2352x1568:
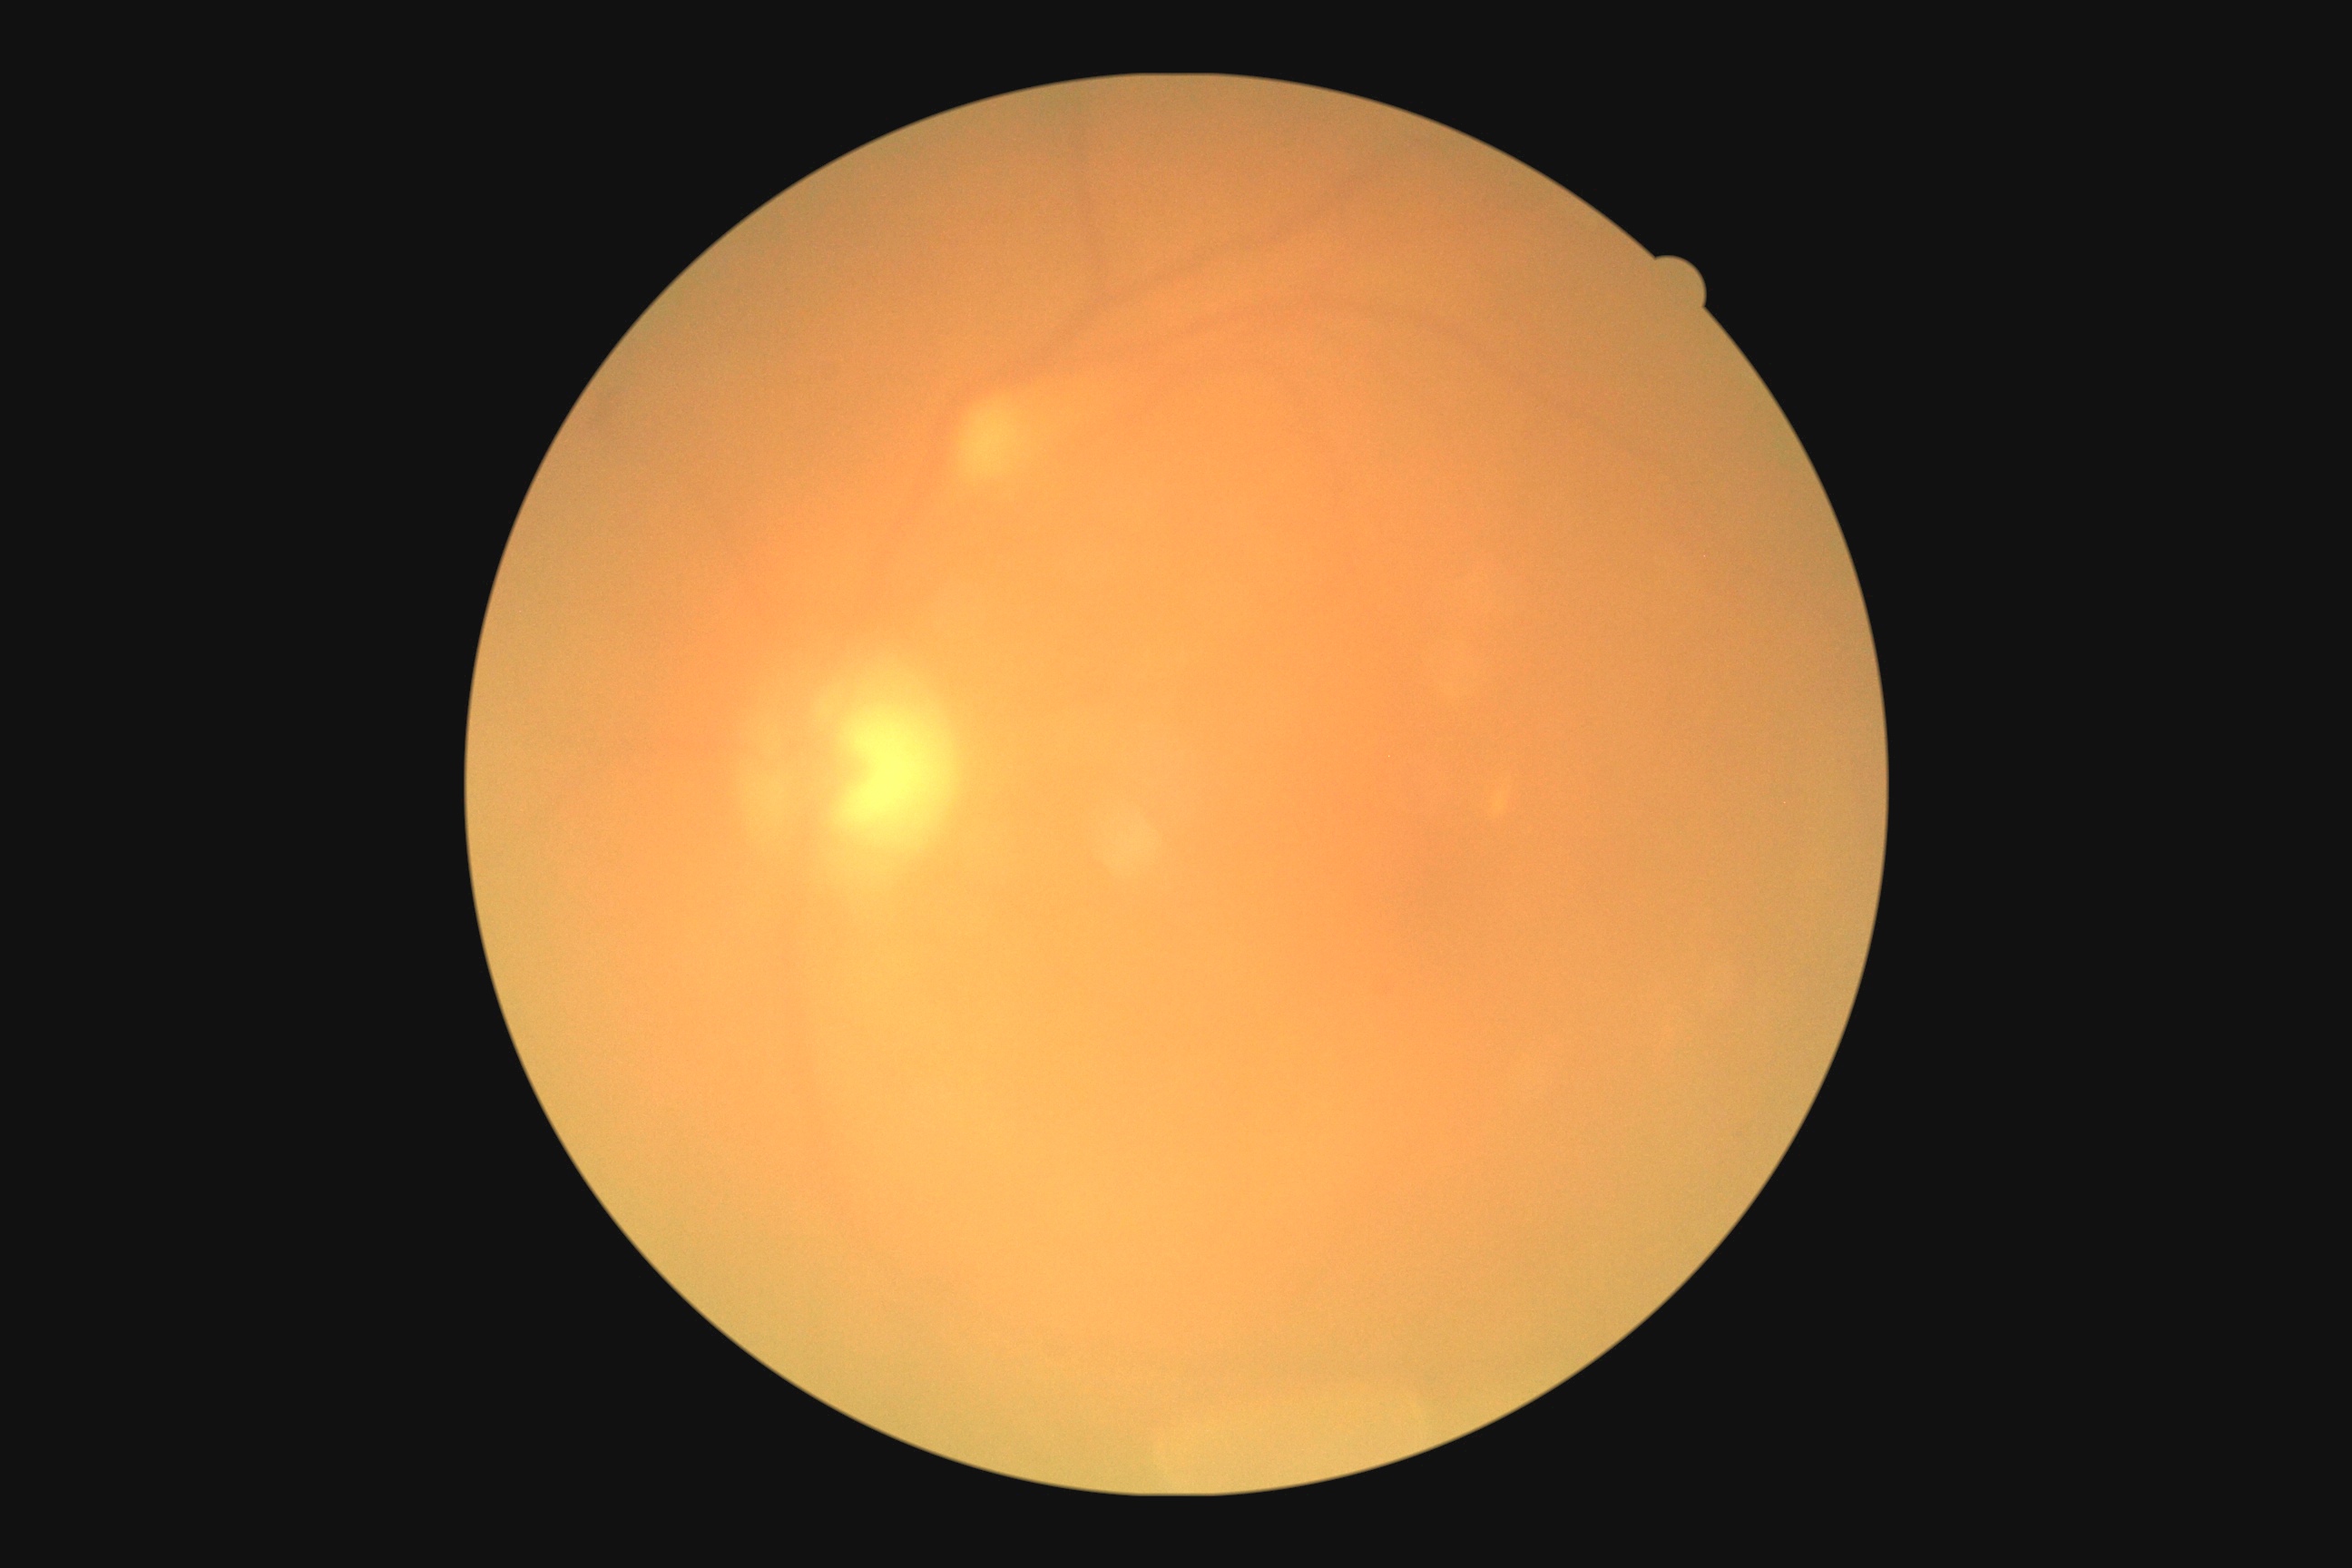 Retinopathy grade is moderate non-proliferative diabetic retinopathy (2).